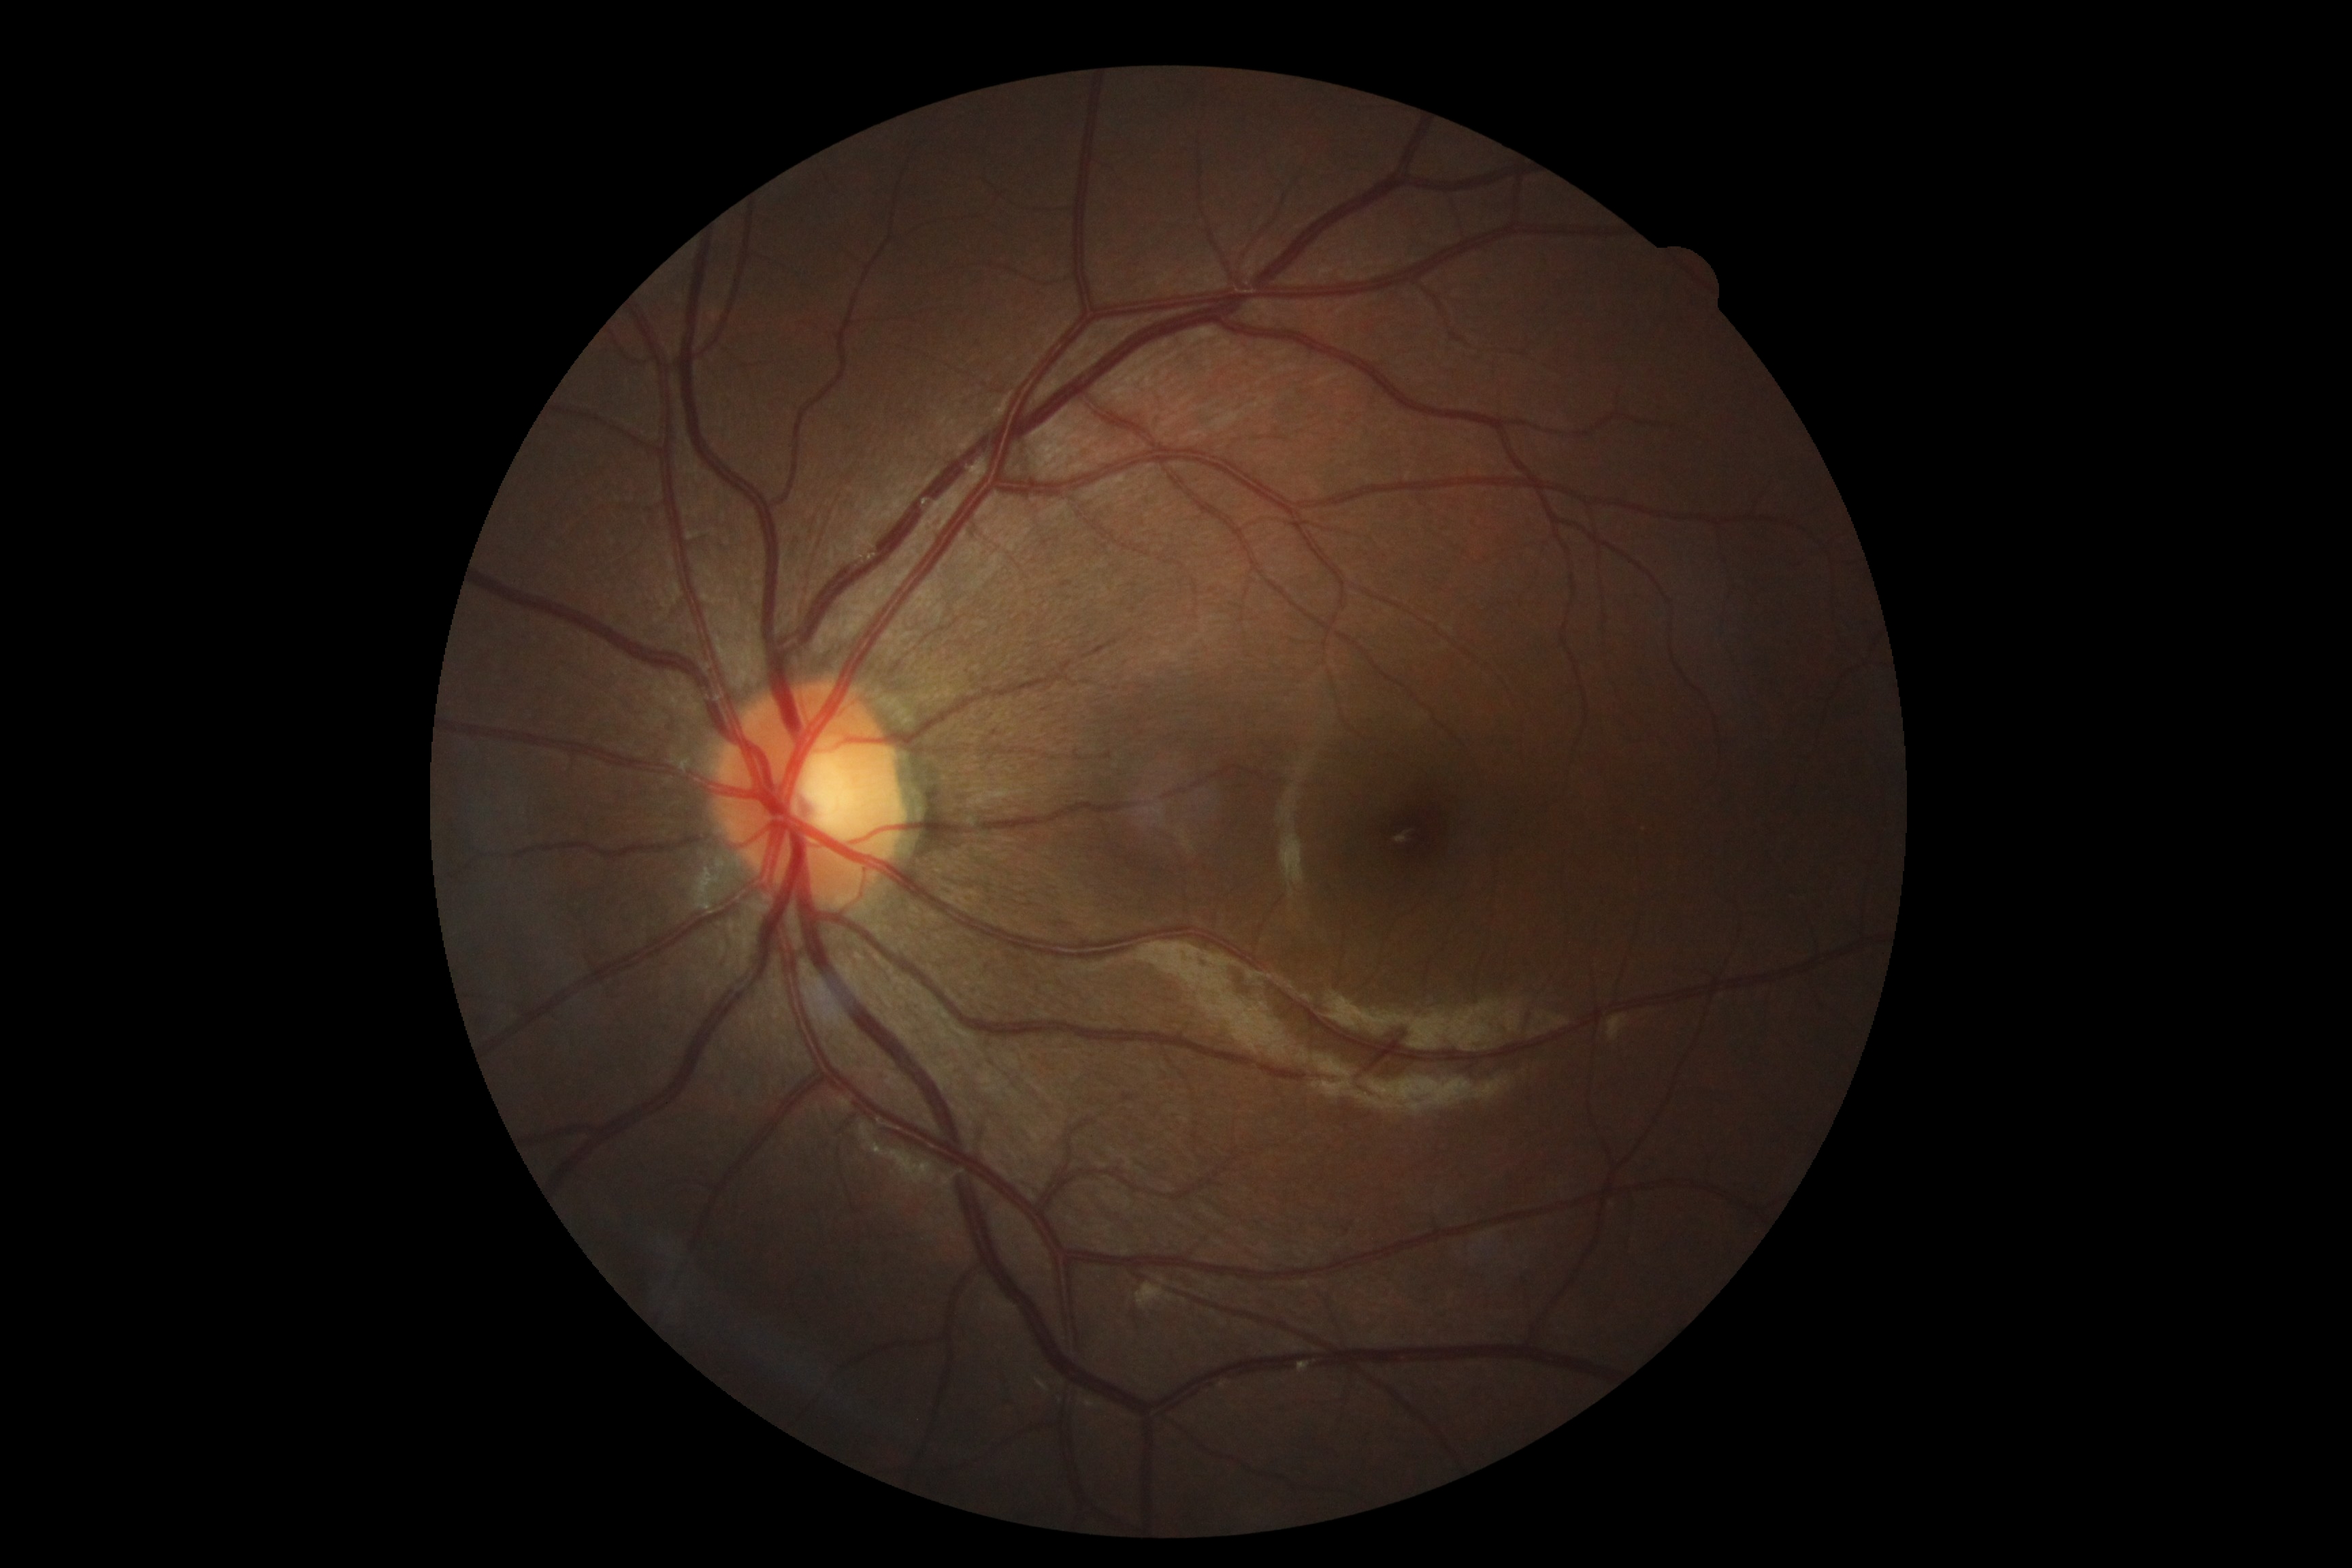 {
  "dr_grade": "grade 0"
}